Camera: NIDEK AFC-230. Davis DR grading. Retinal fundus photograph: 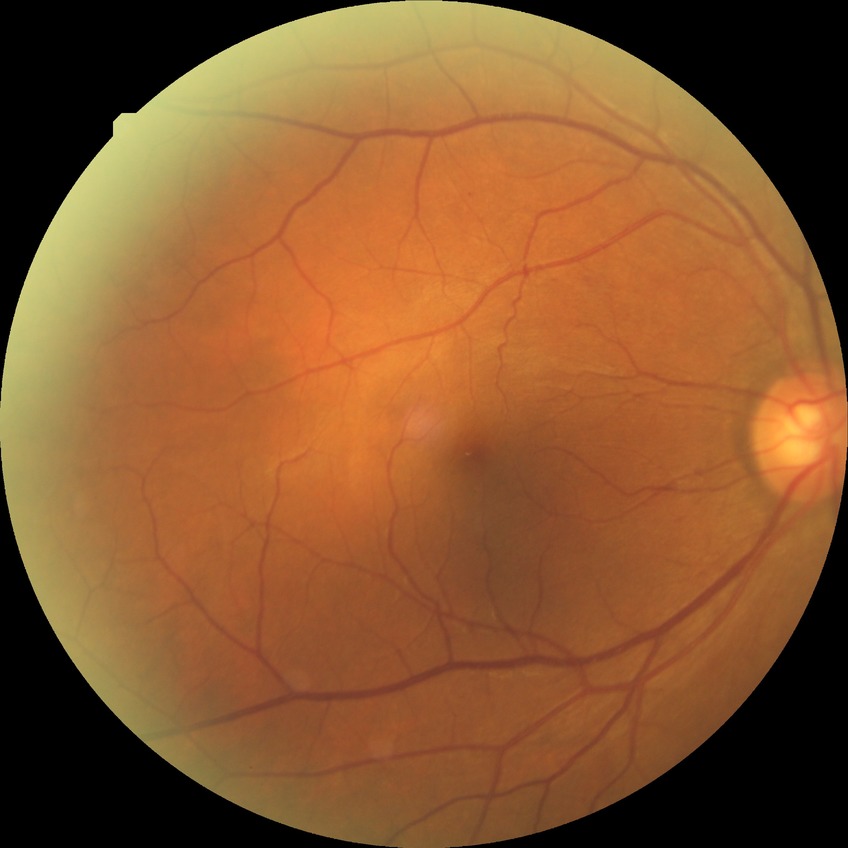 Modified Davis grade is NDR.